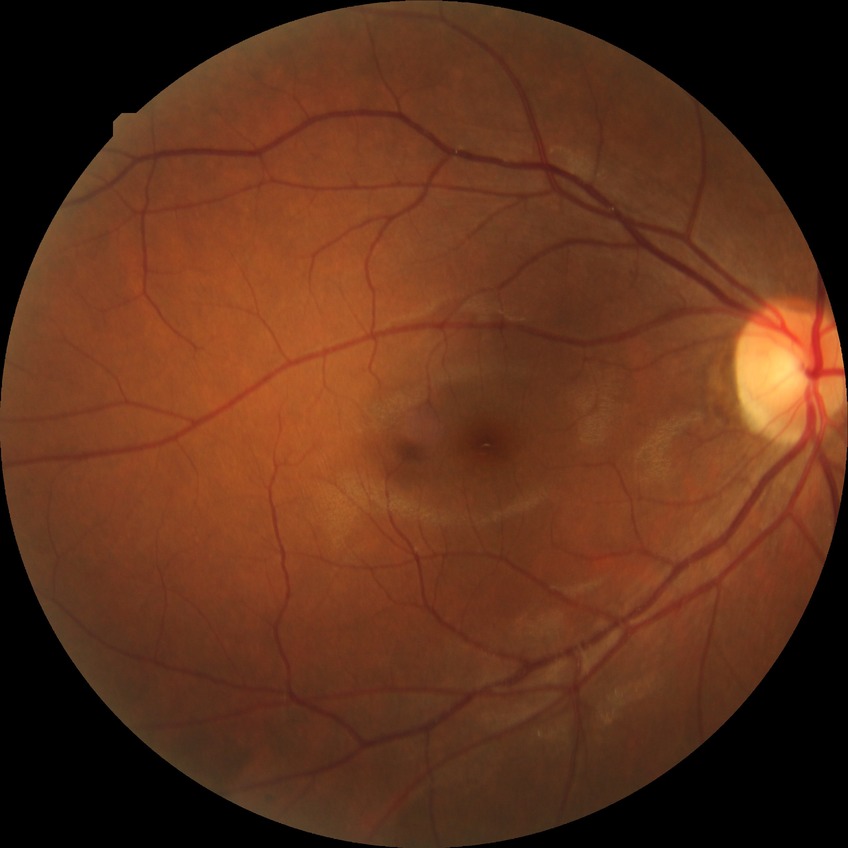
Diabetic retinopathy stage: simple diabetic retinopathy.
Disease class: non-proliferative diabetic retinopathy.